Davis DR grading.
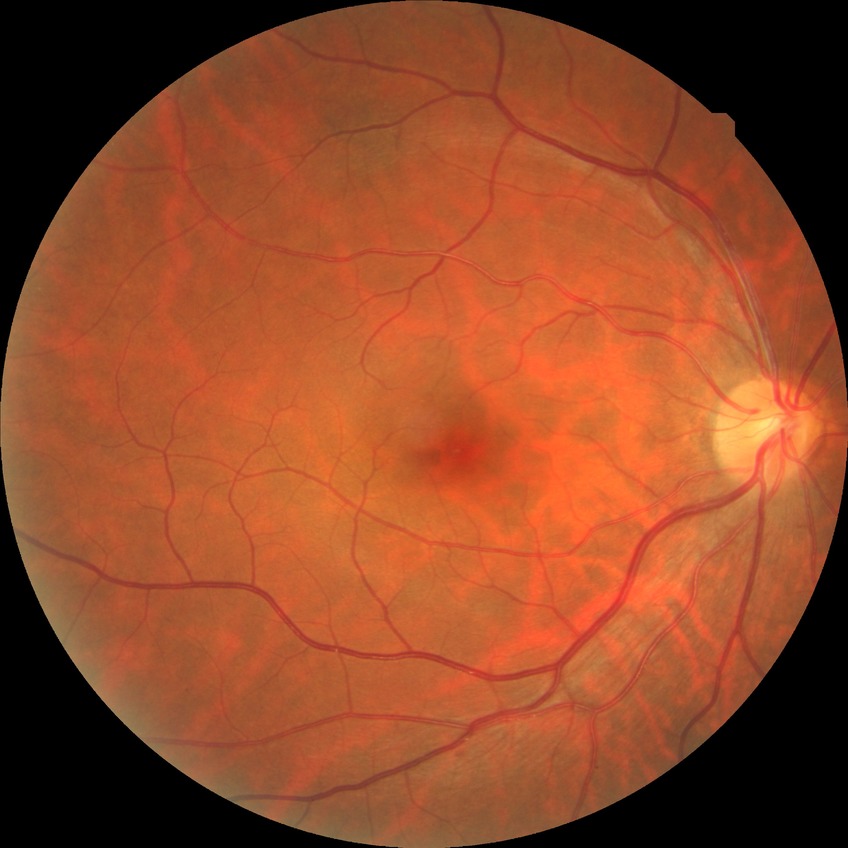

Diabetic retinopathy (DR): no diabetic retinopathy (NDR).